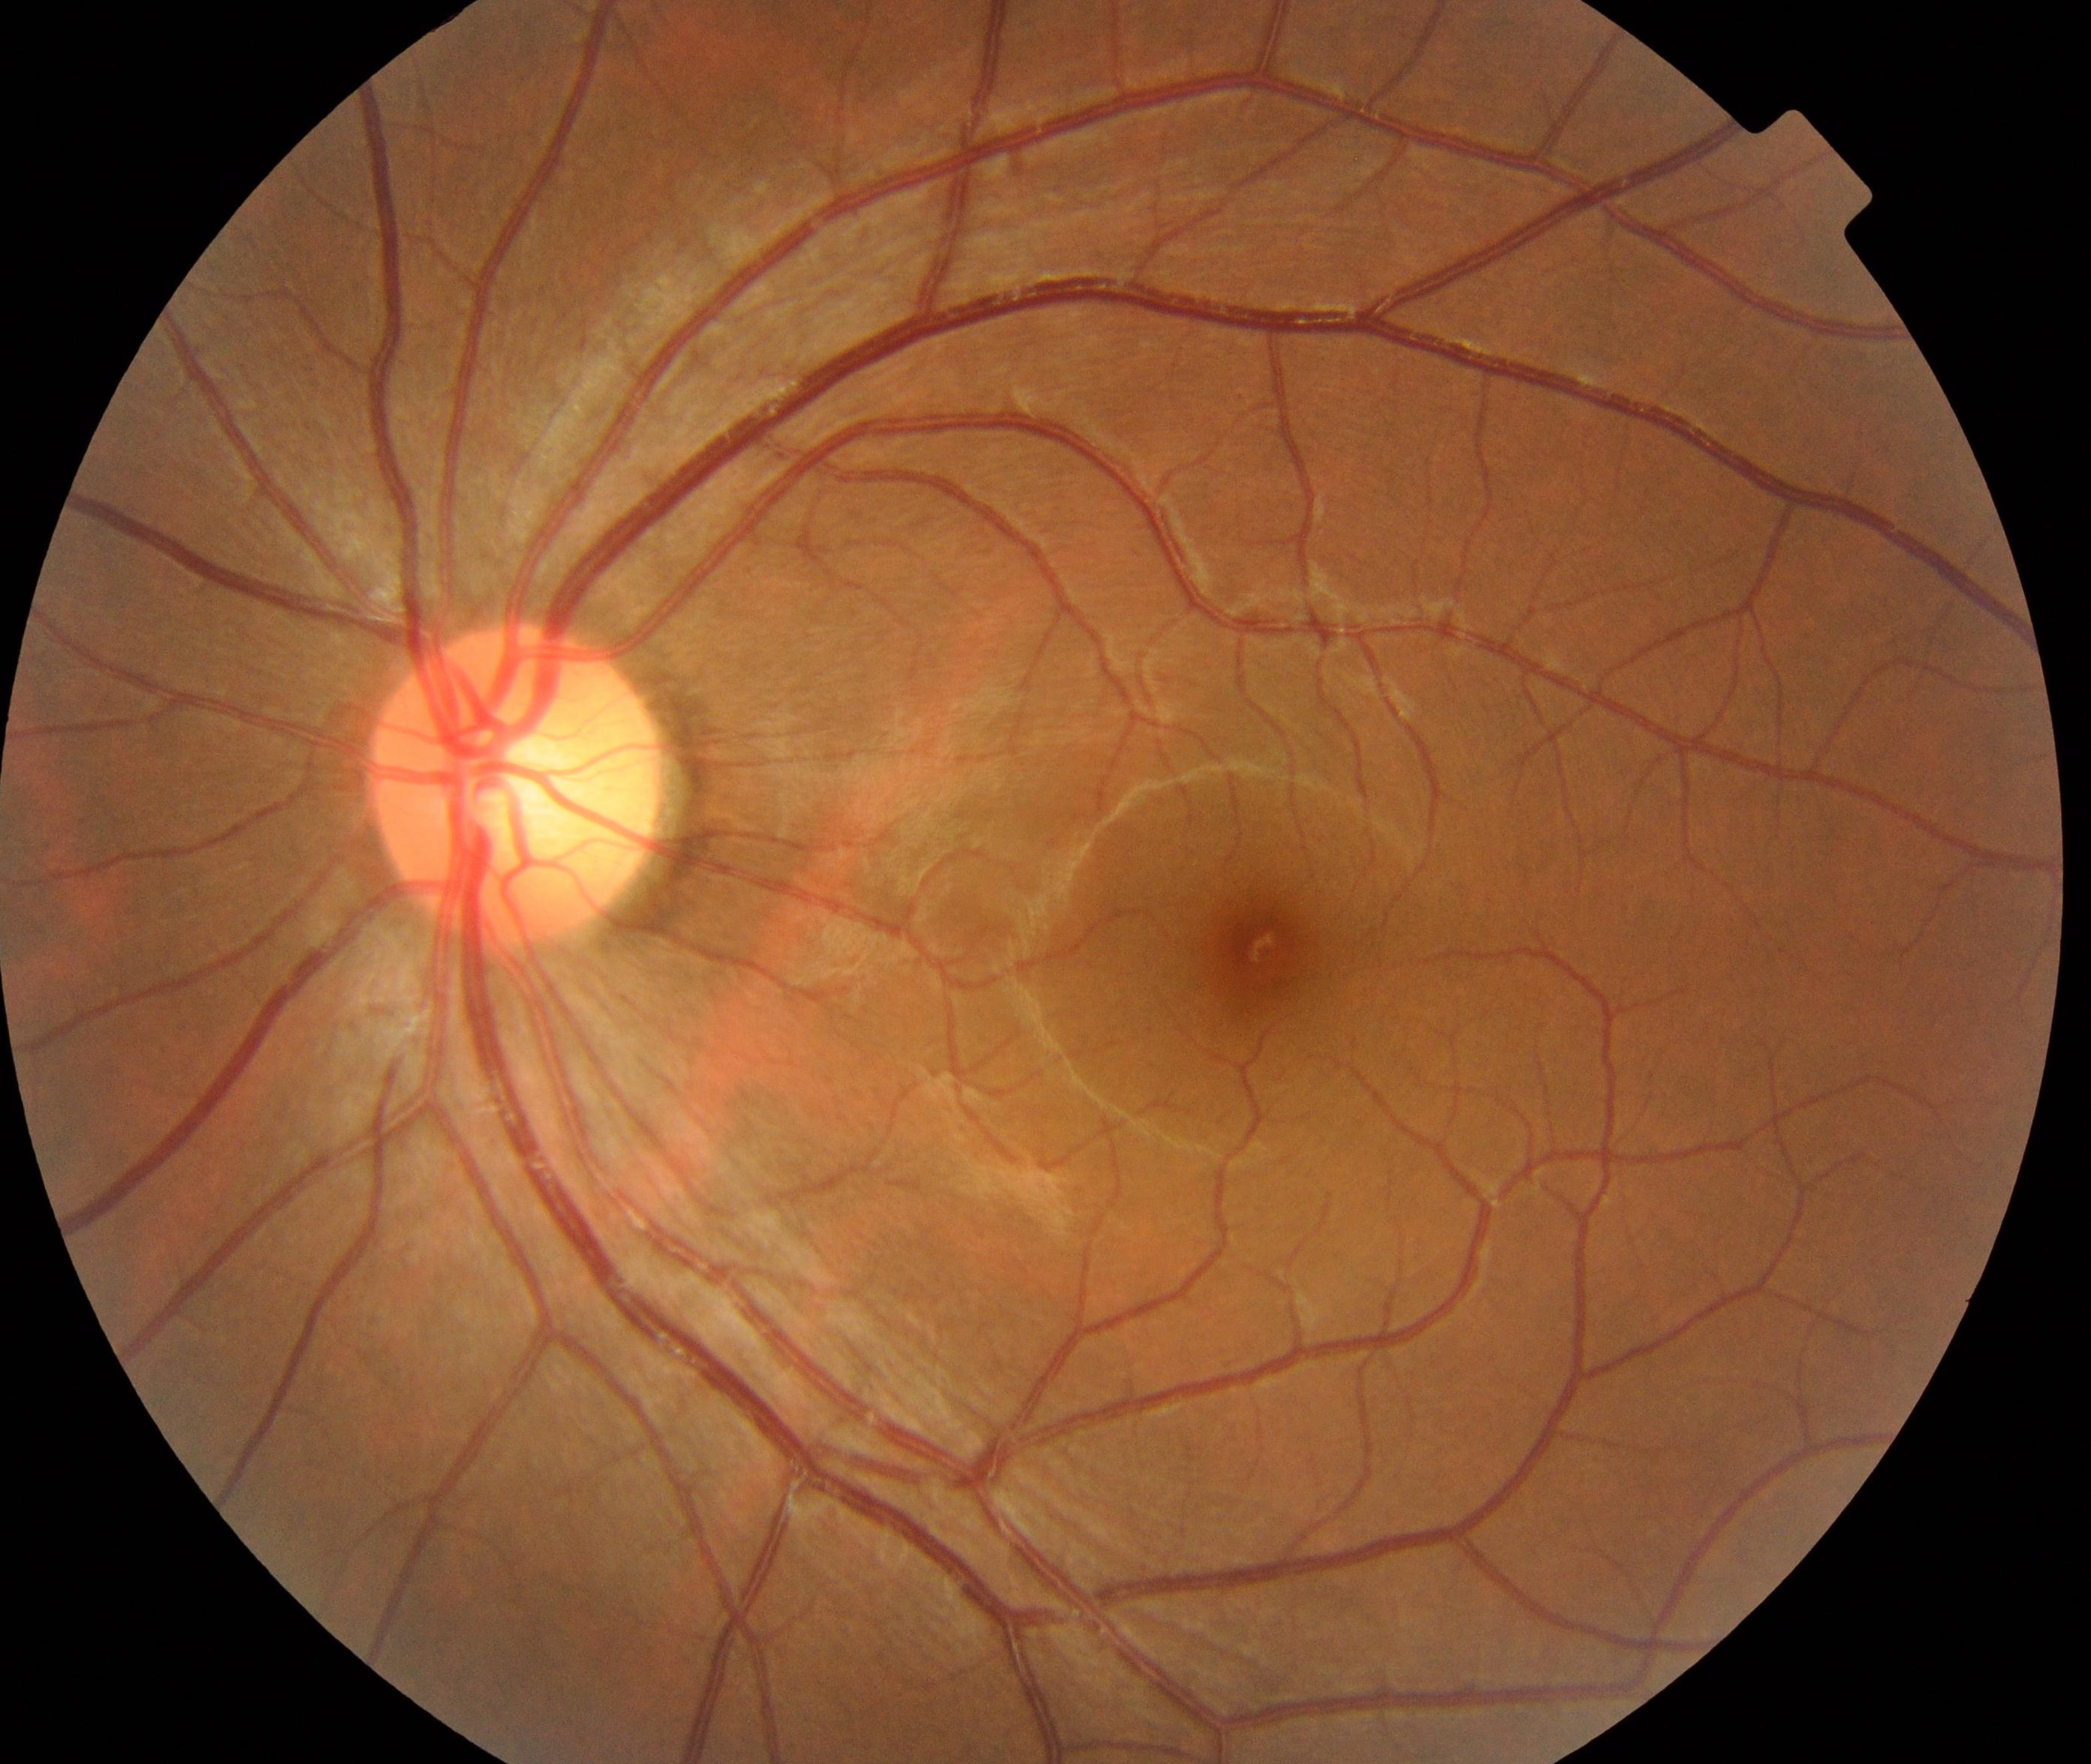
Within normal limits. No abnormalities identified.